Portable fundus camera image. FOV: 60 degrees: 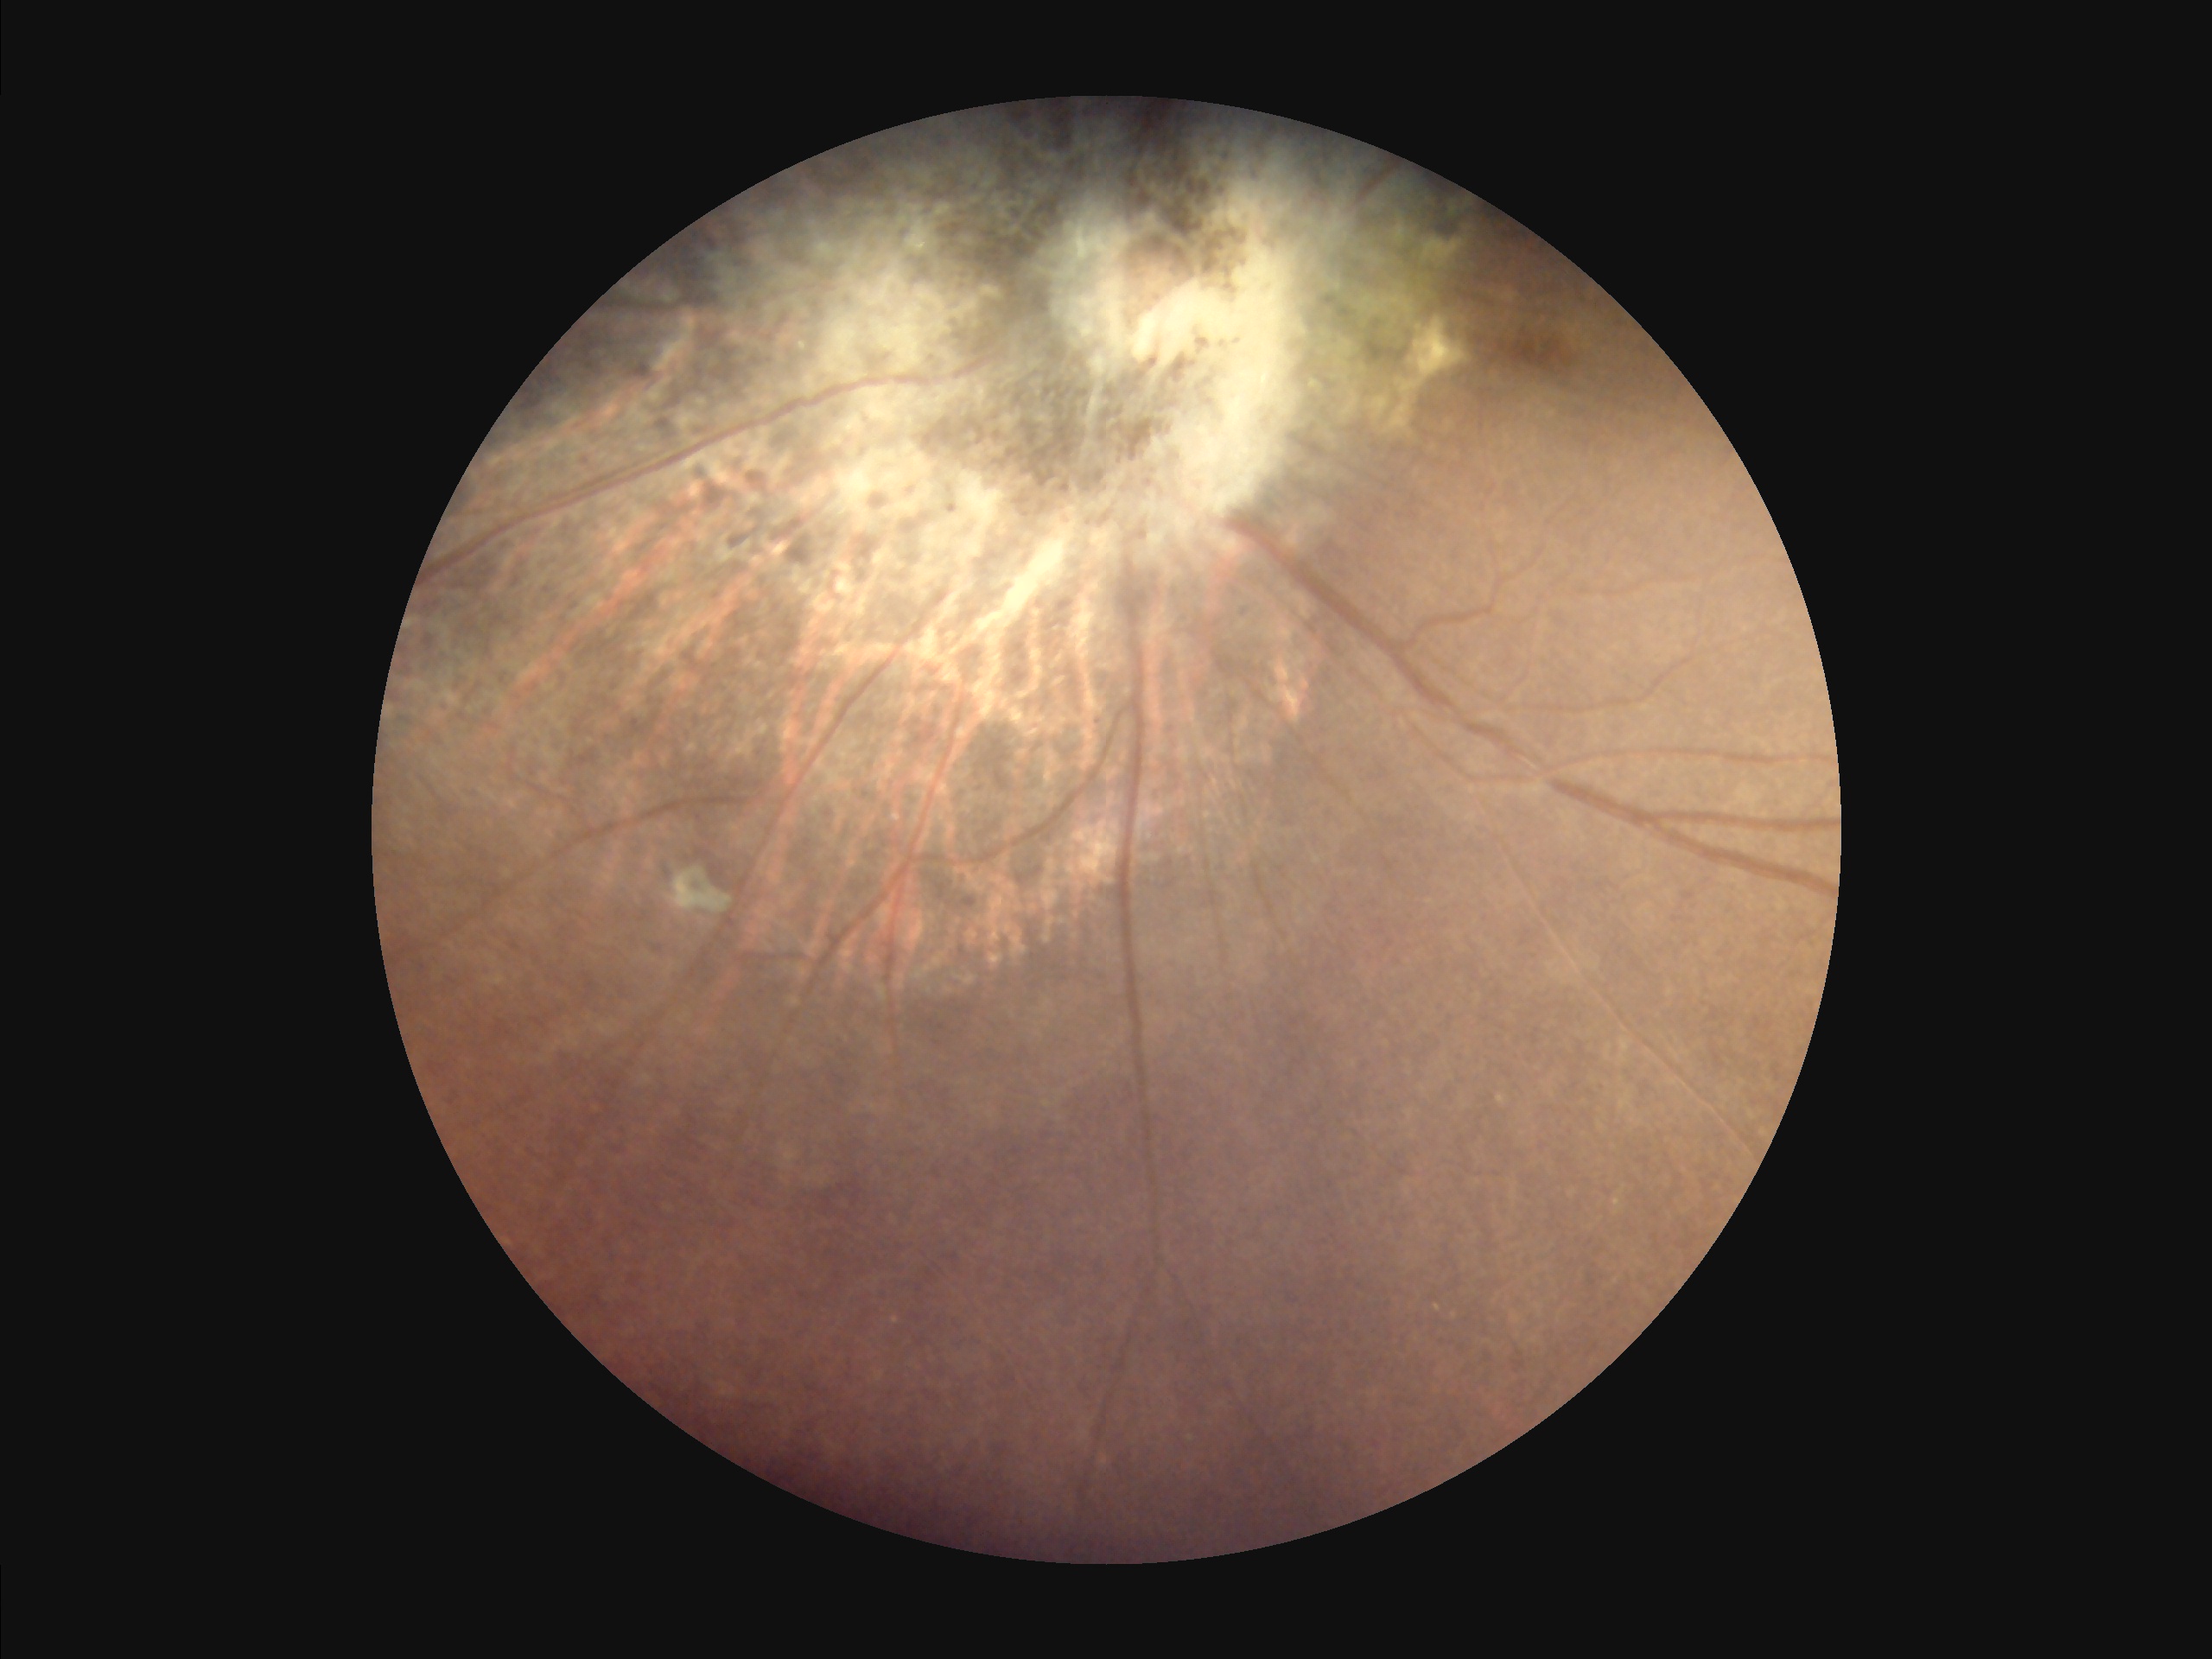

Noticeable blur in the optic disc, vessels, or background.
Image quality is suboptimal.
No over- or under-exposure.
Adequate contrast for distinguishing structures.